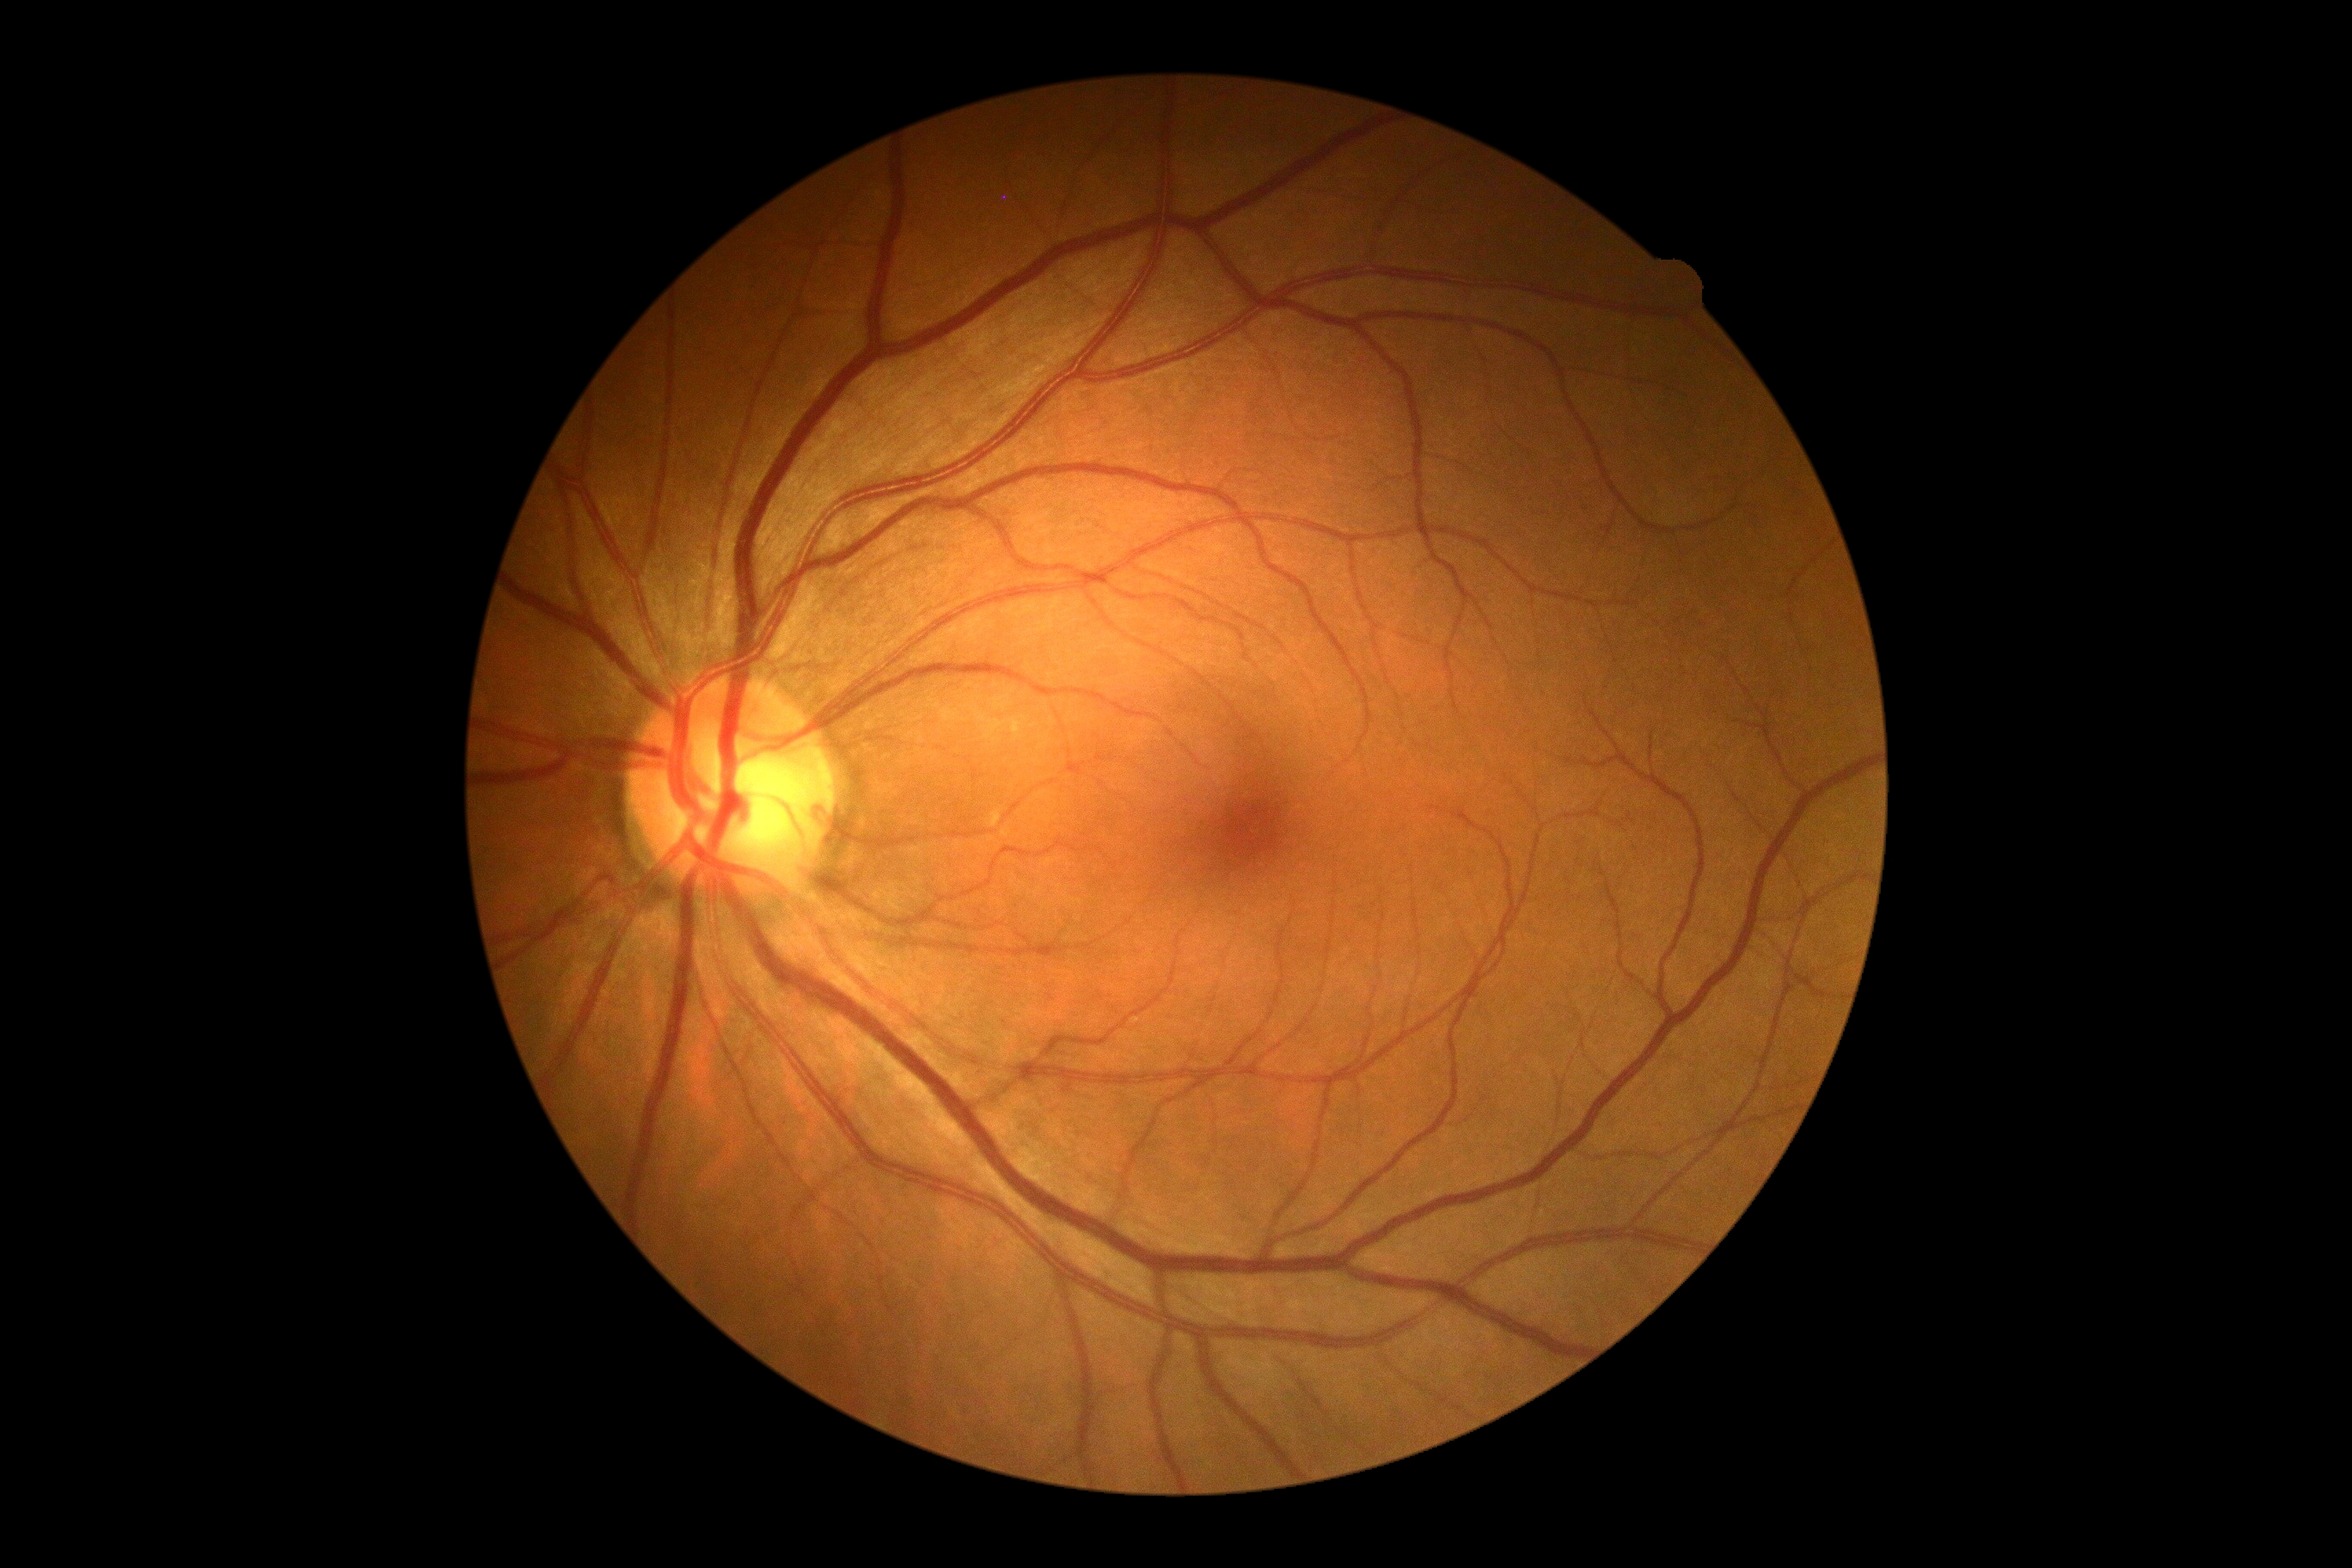

– DR impression — no DR findings
– retinopathy — grade 0 (no apparent retinopathy)